CFP: 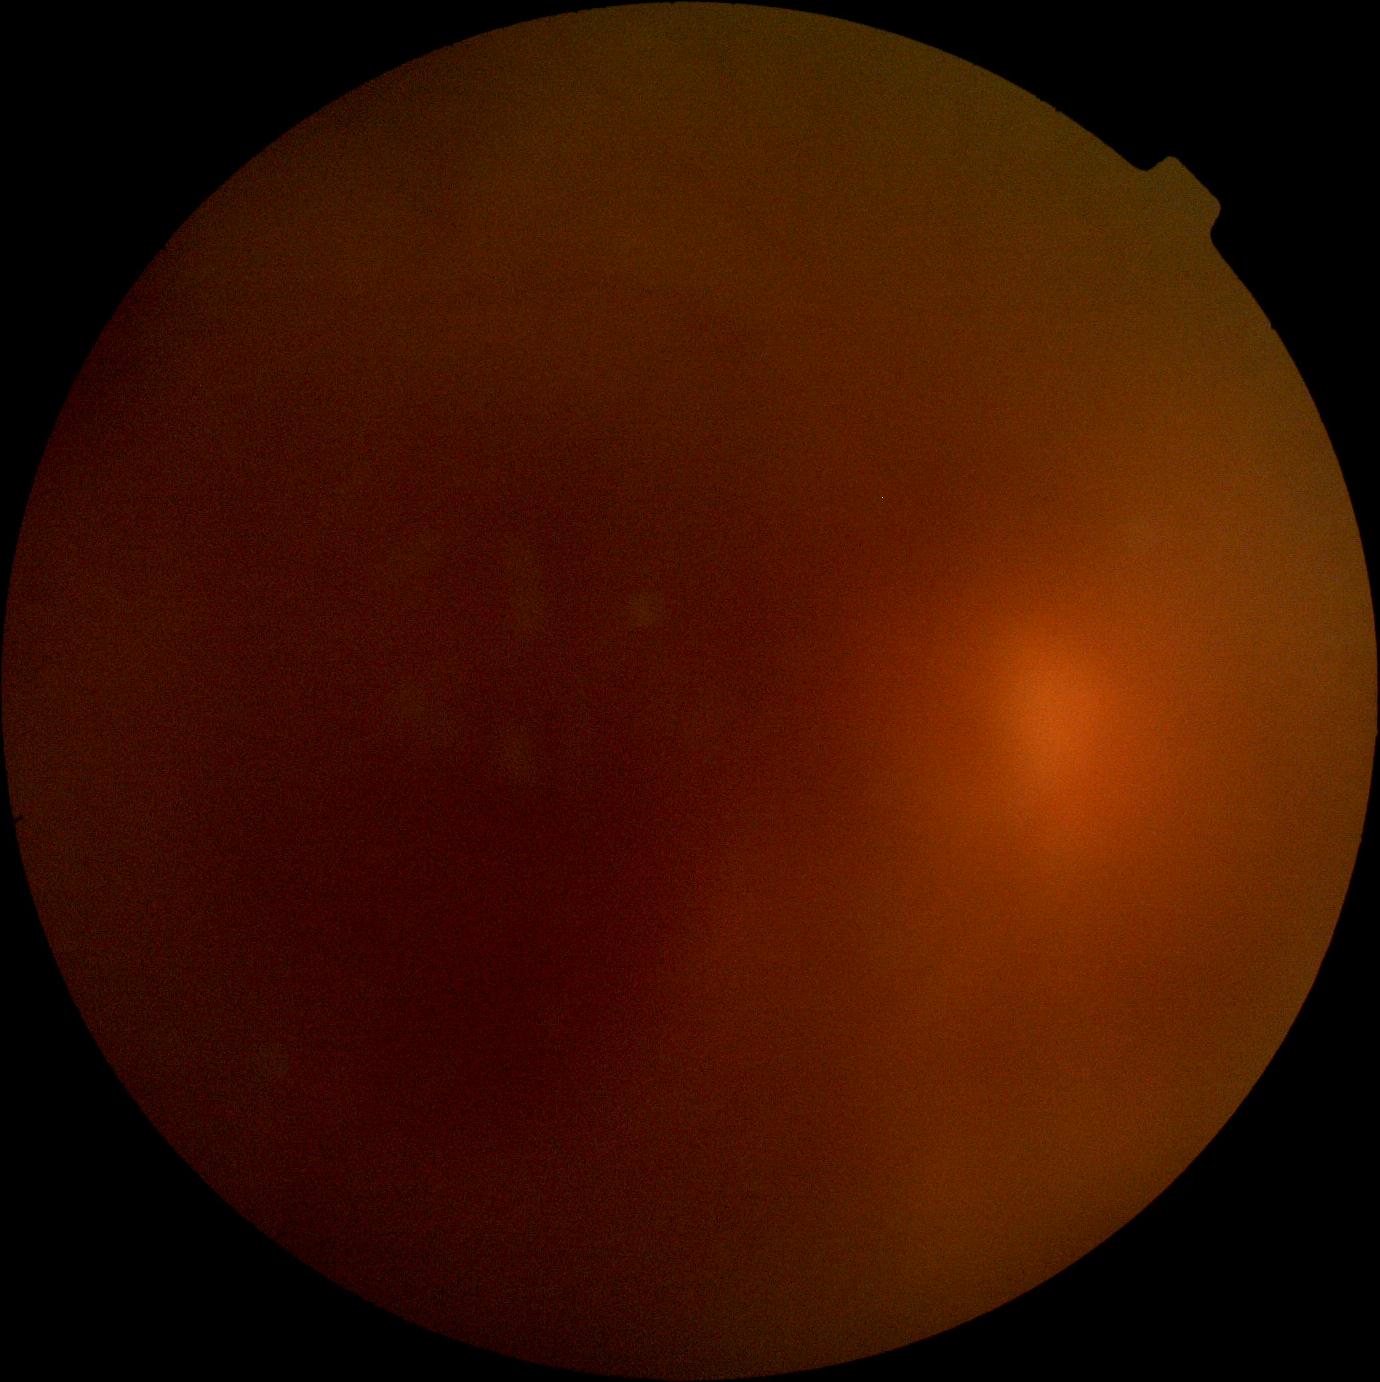 Retinopathy grade: ungradable due to poor image quality. Image quality is insufficient for diabetic retinopathy assessment.